Phoenix ICON, 100° FOV; infant wide-field fundus photograph; 1240x1240 — 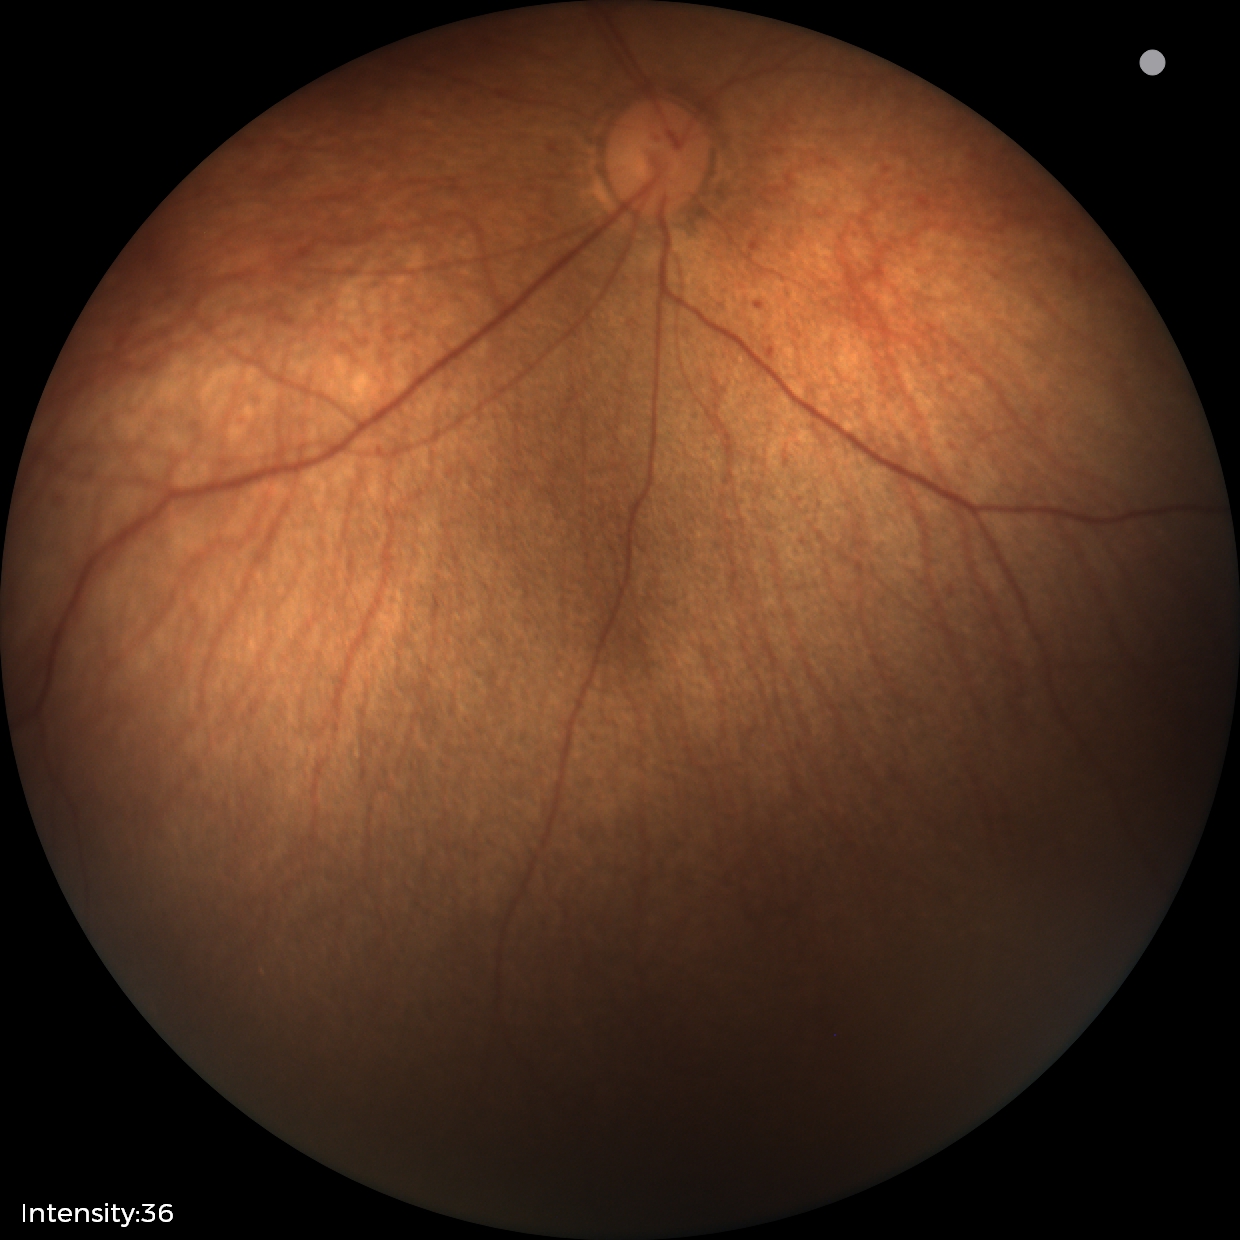
Screening examination diagnosed as physiological.